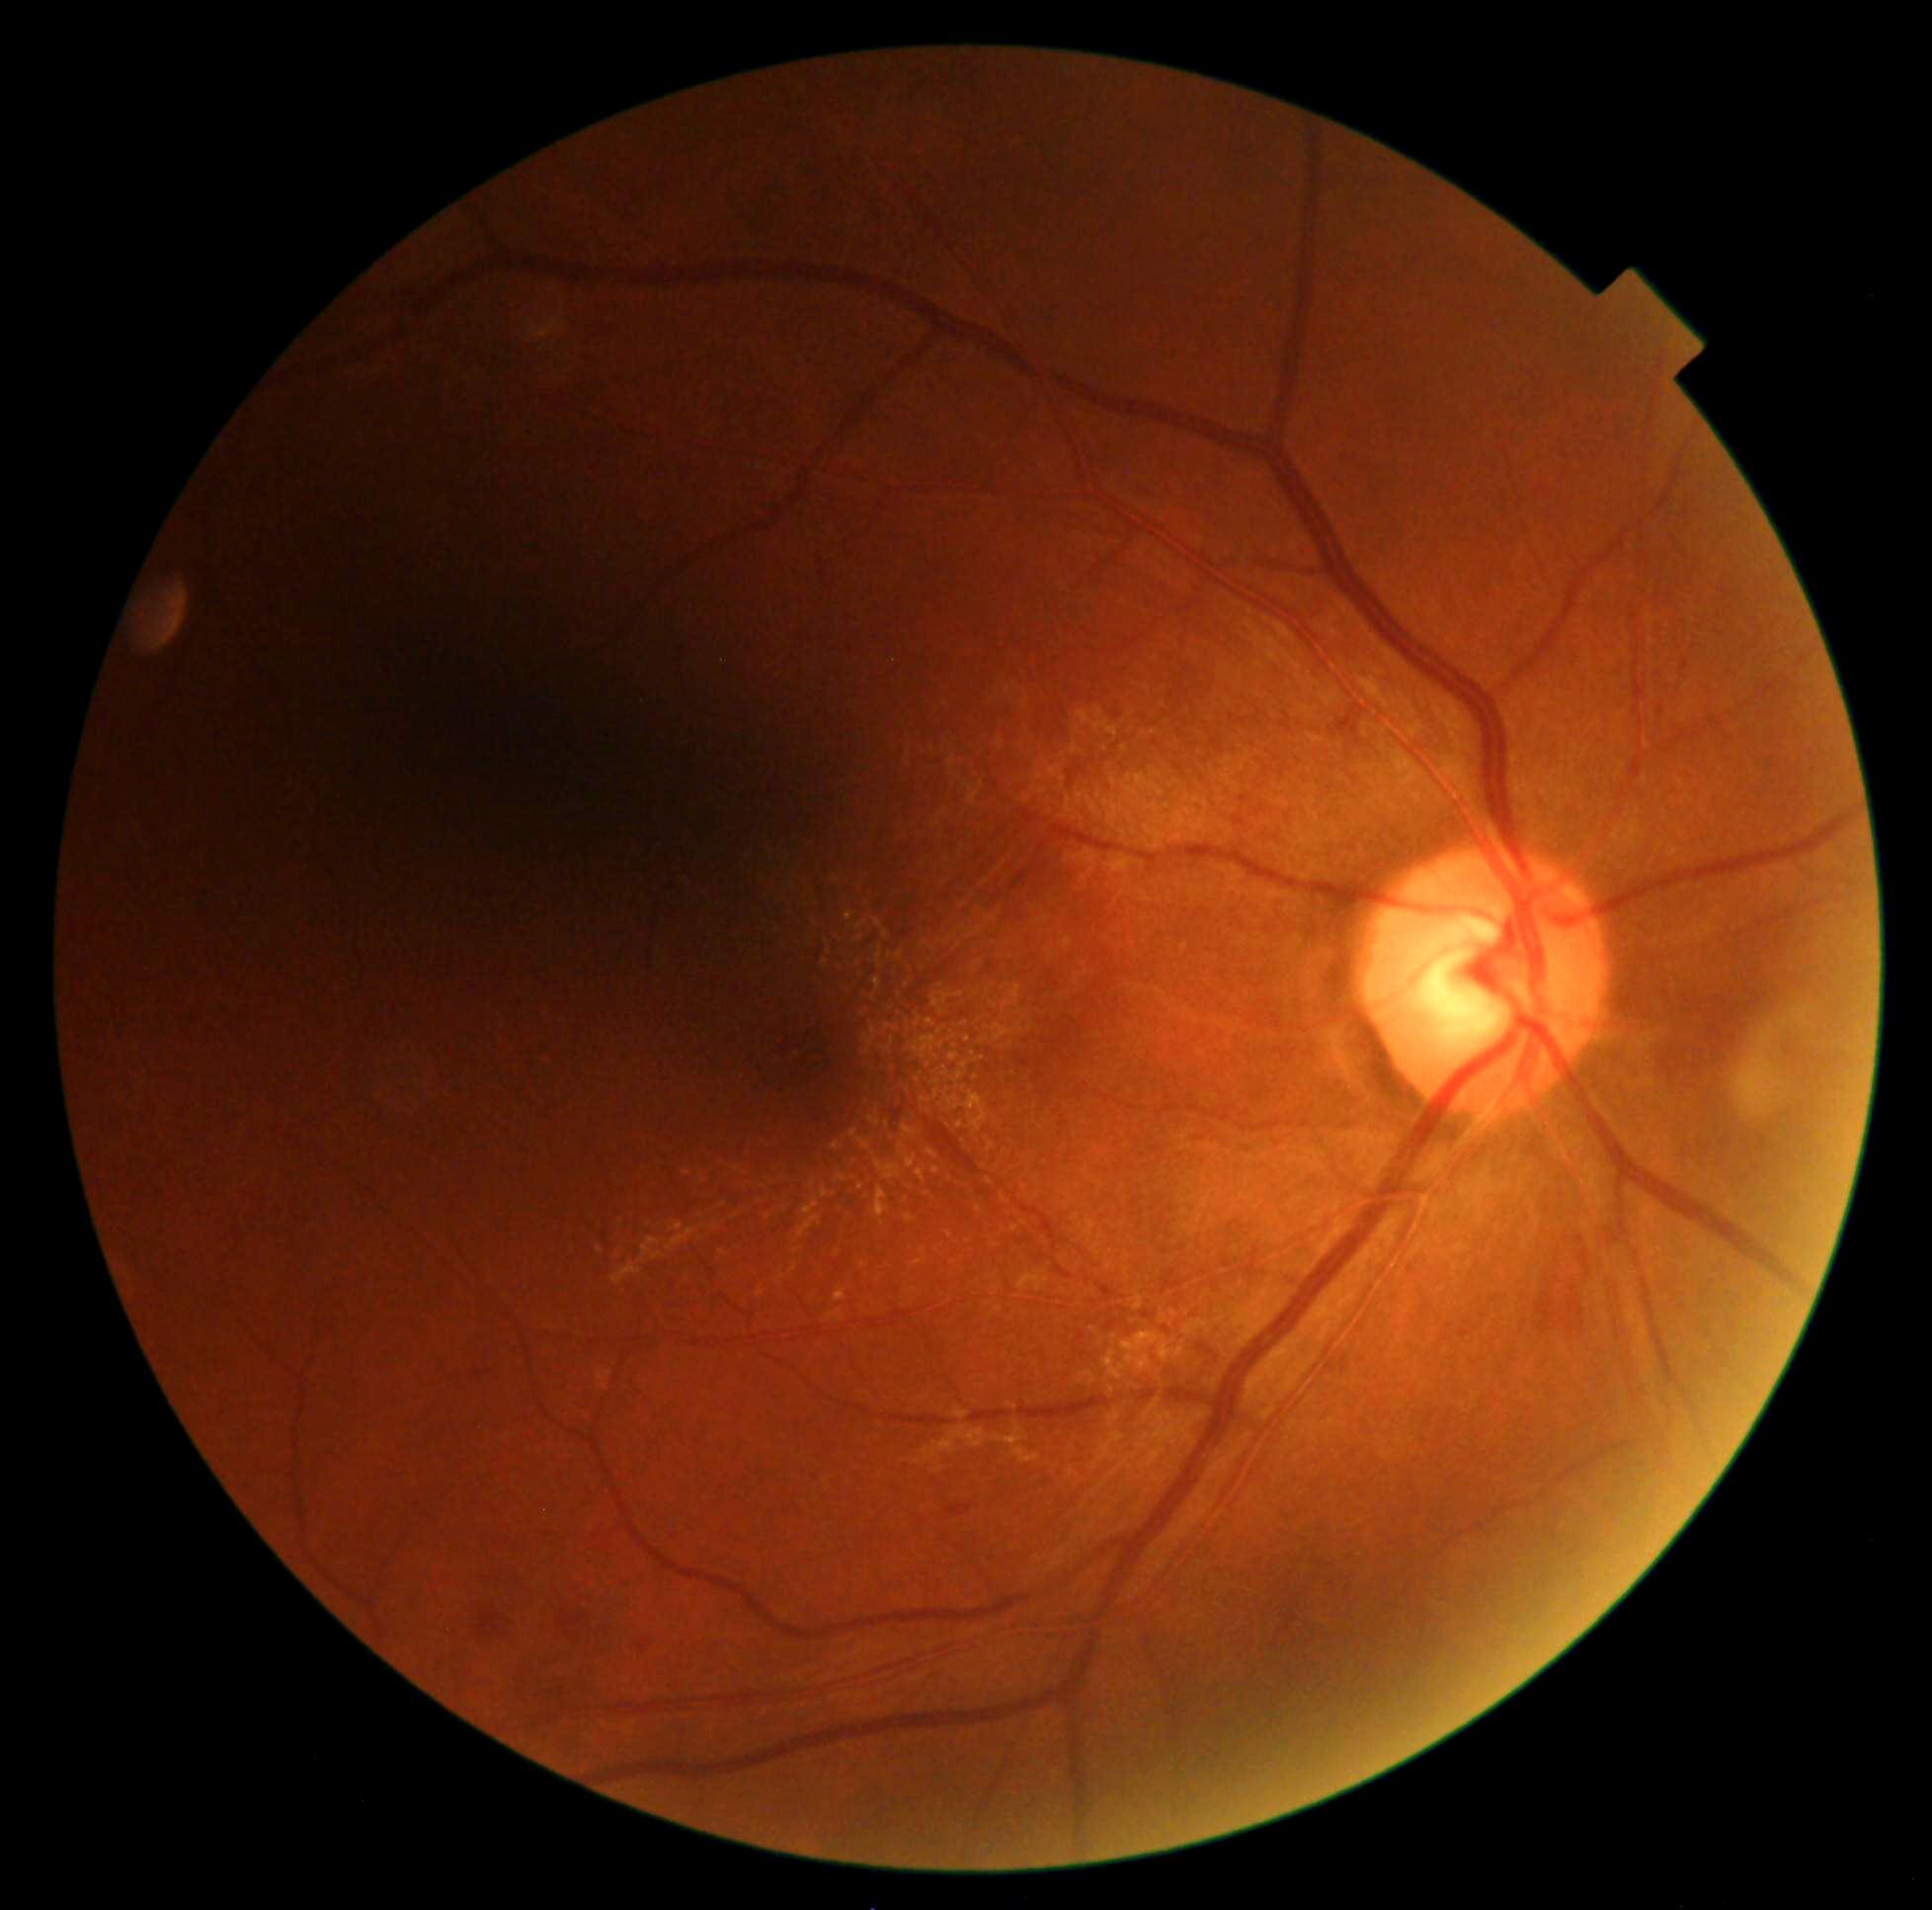 DR grade: 2.